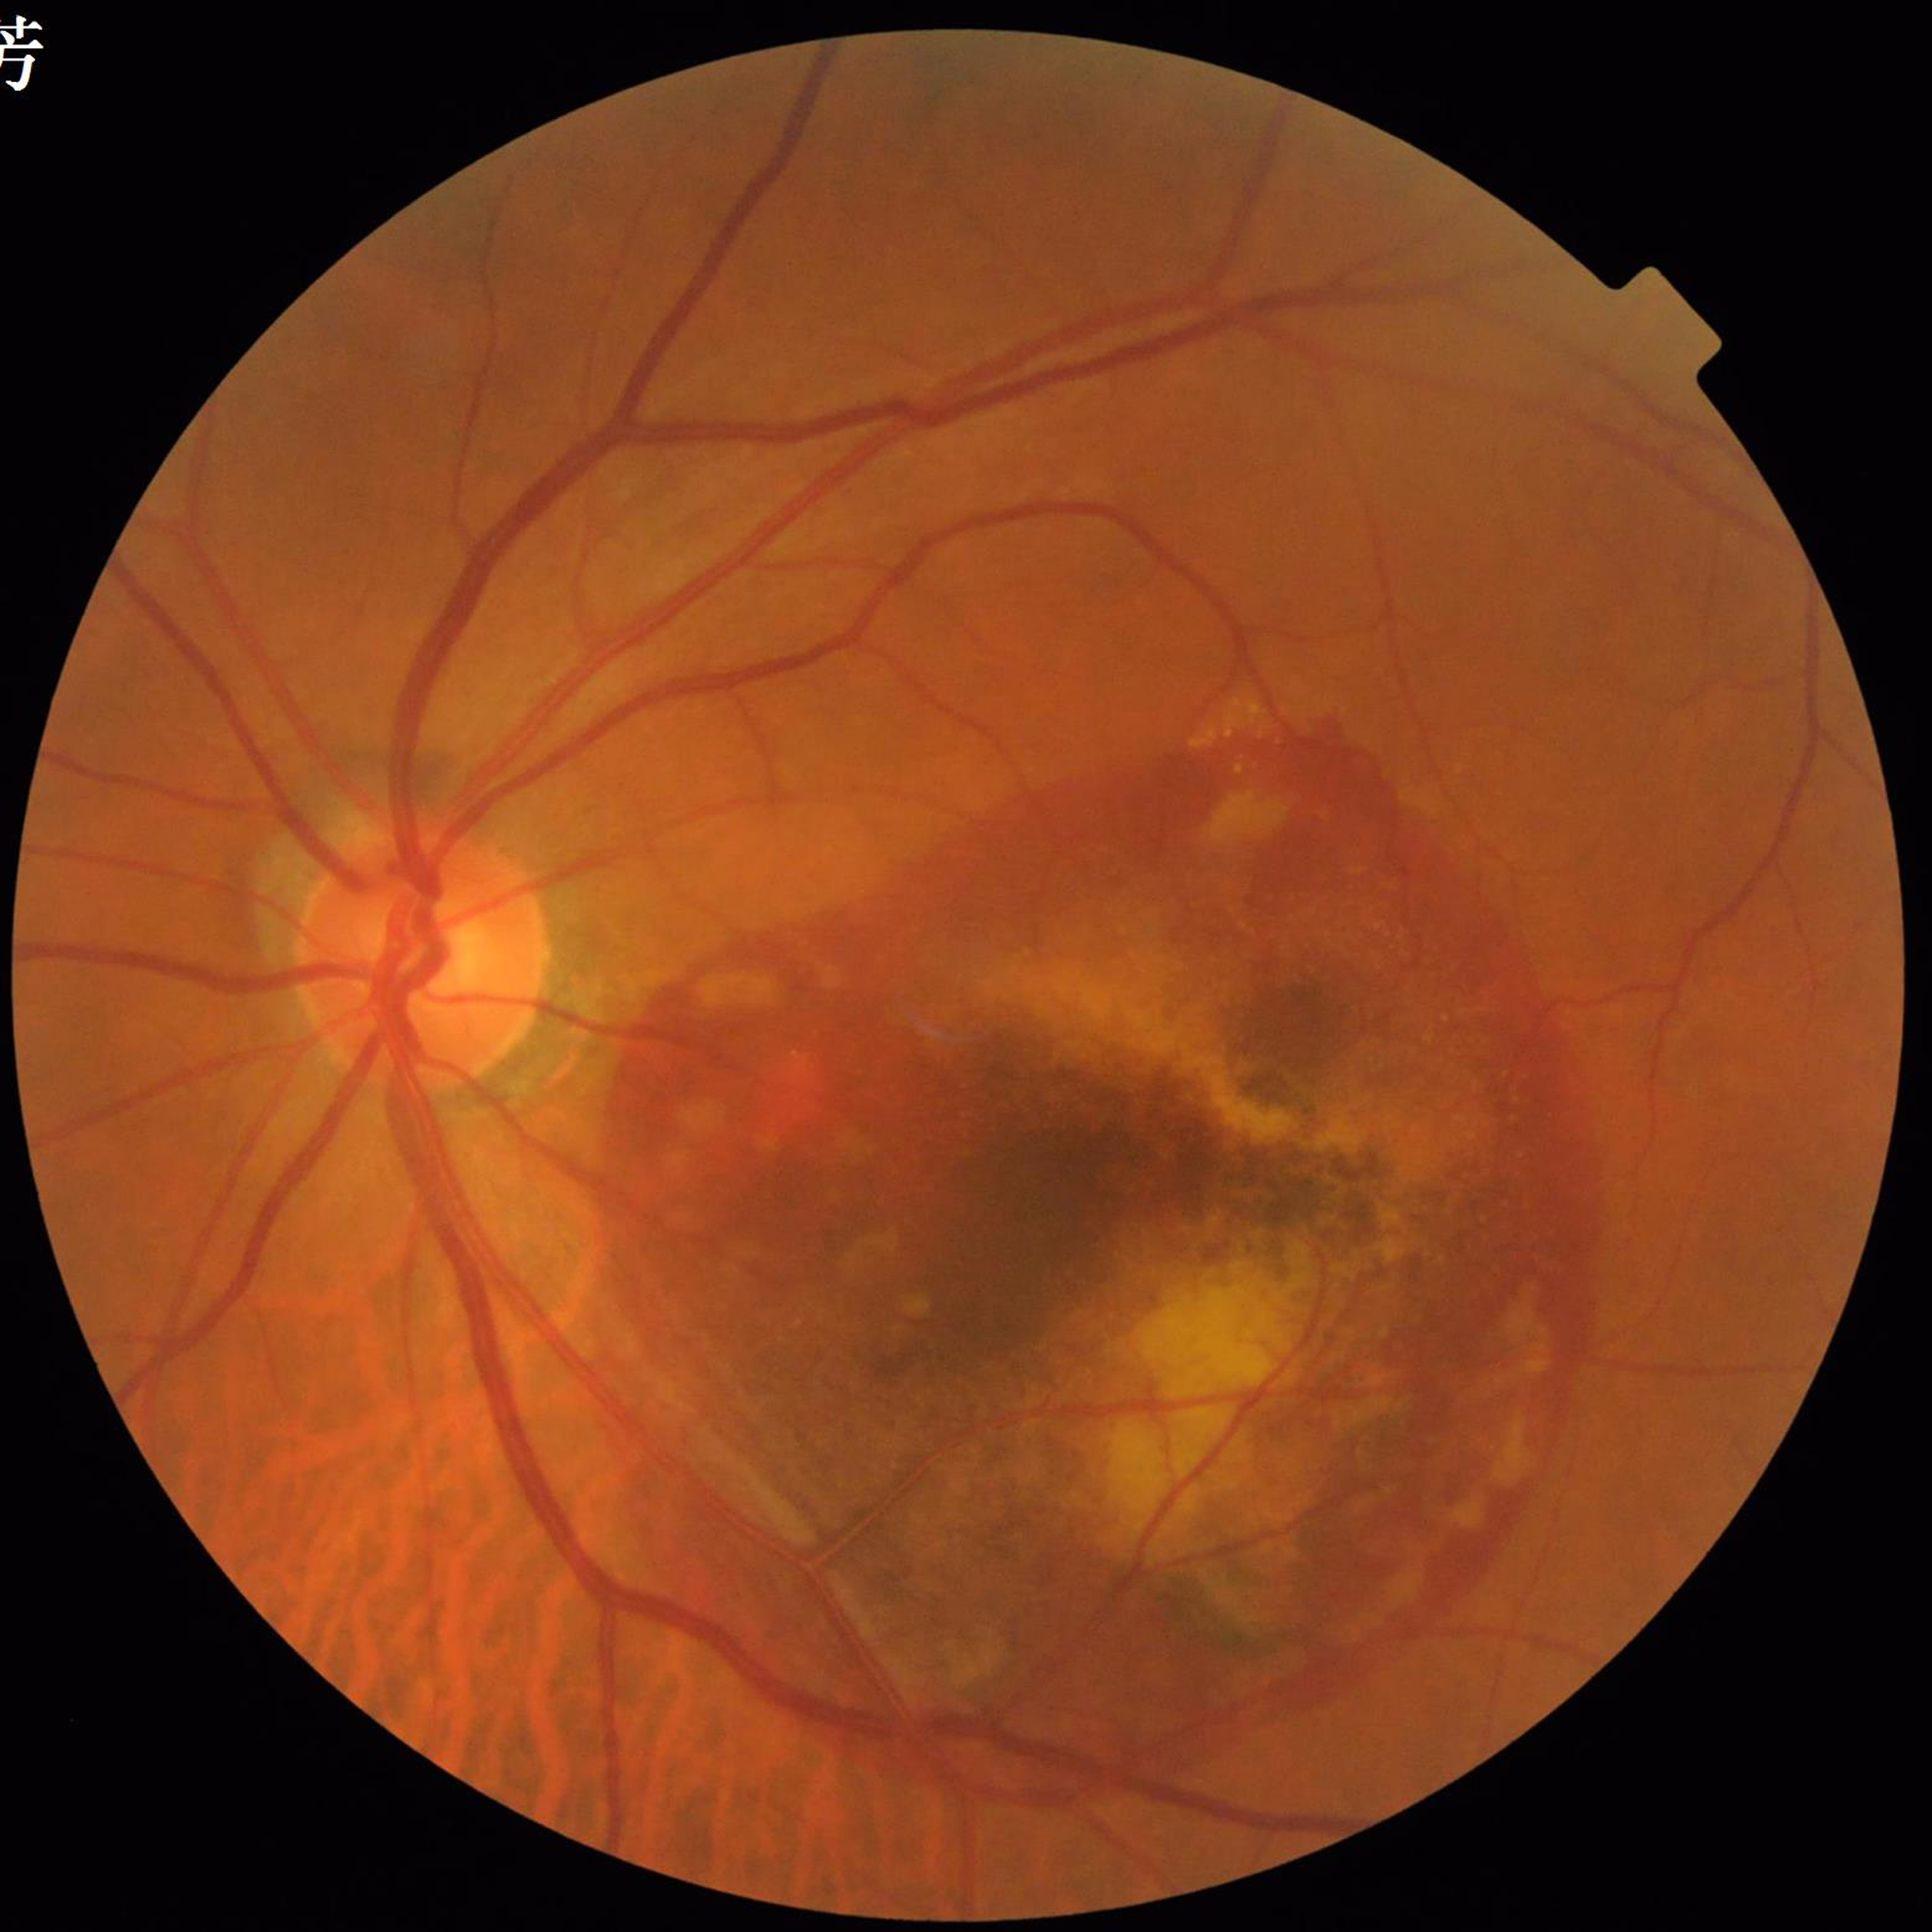

Eye affected by age-related macular degeneration. Automated quality assessment: satisfactory.